45° FOV:
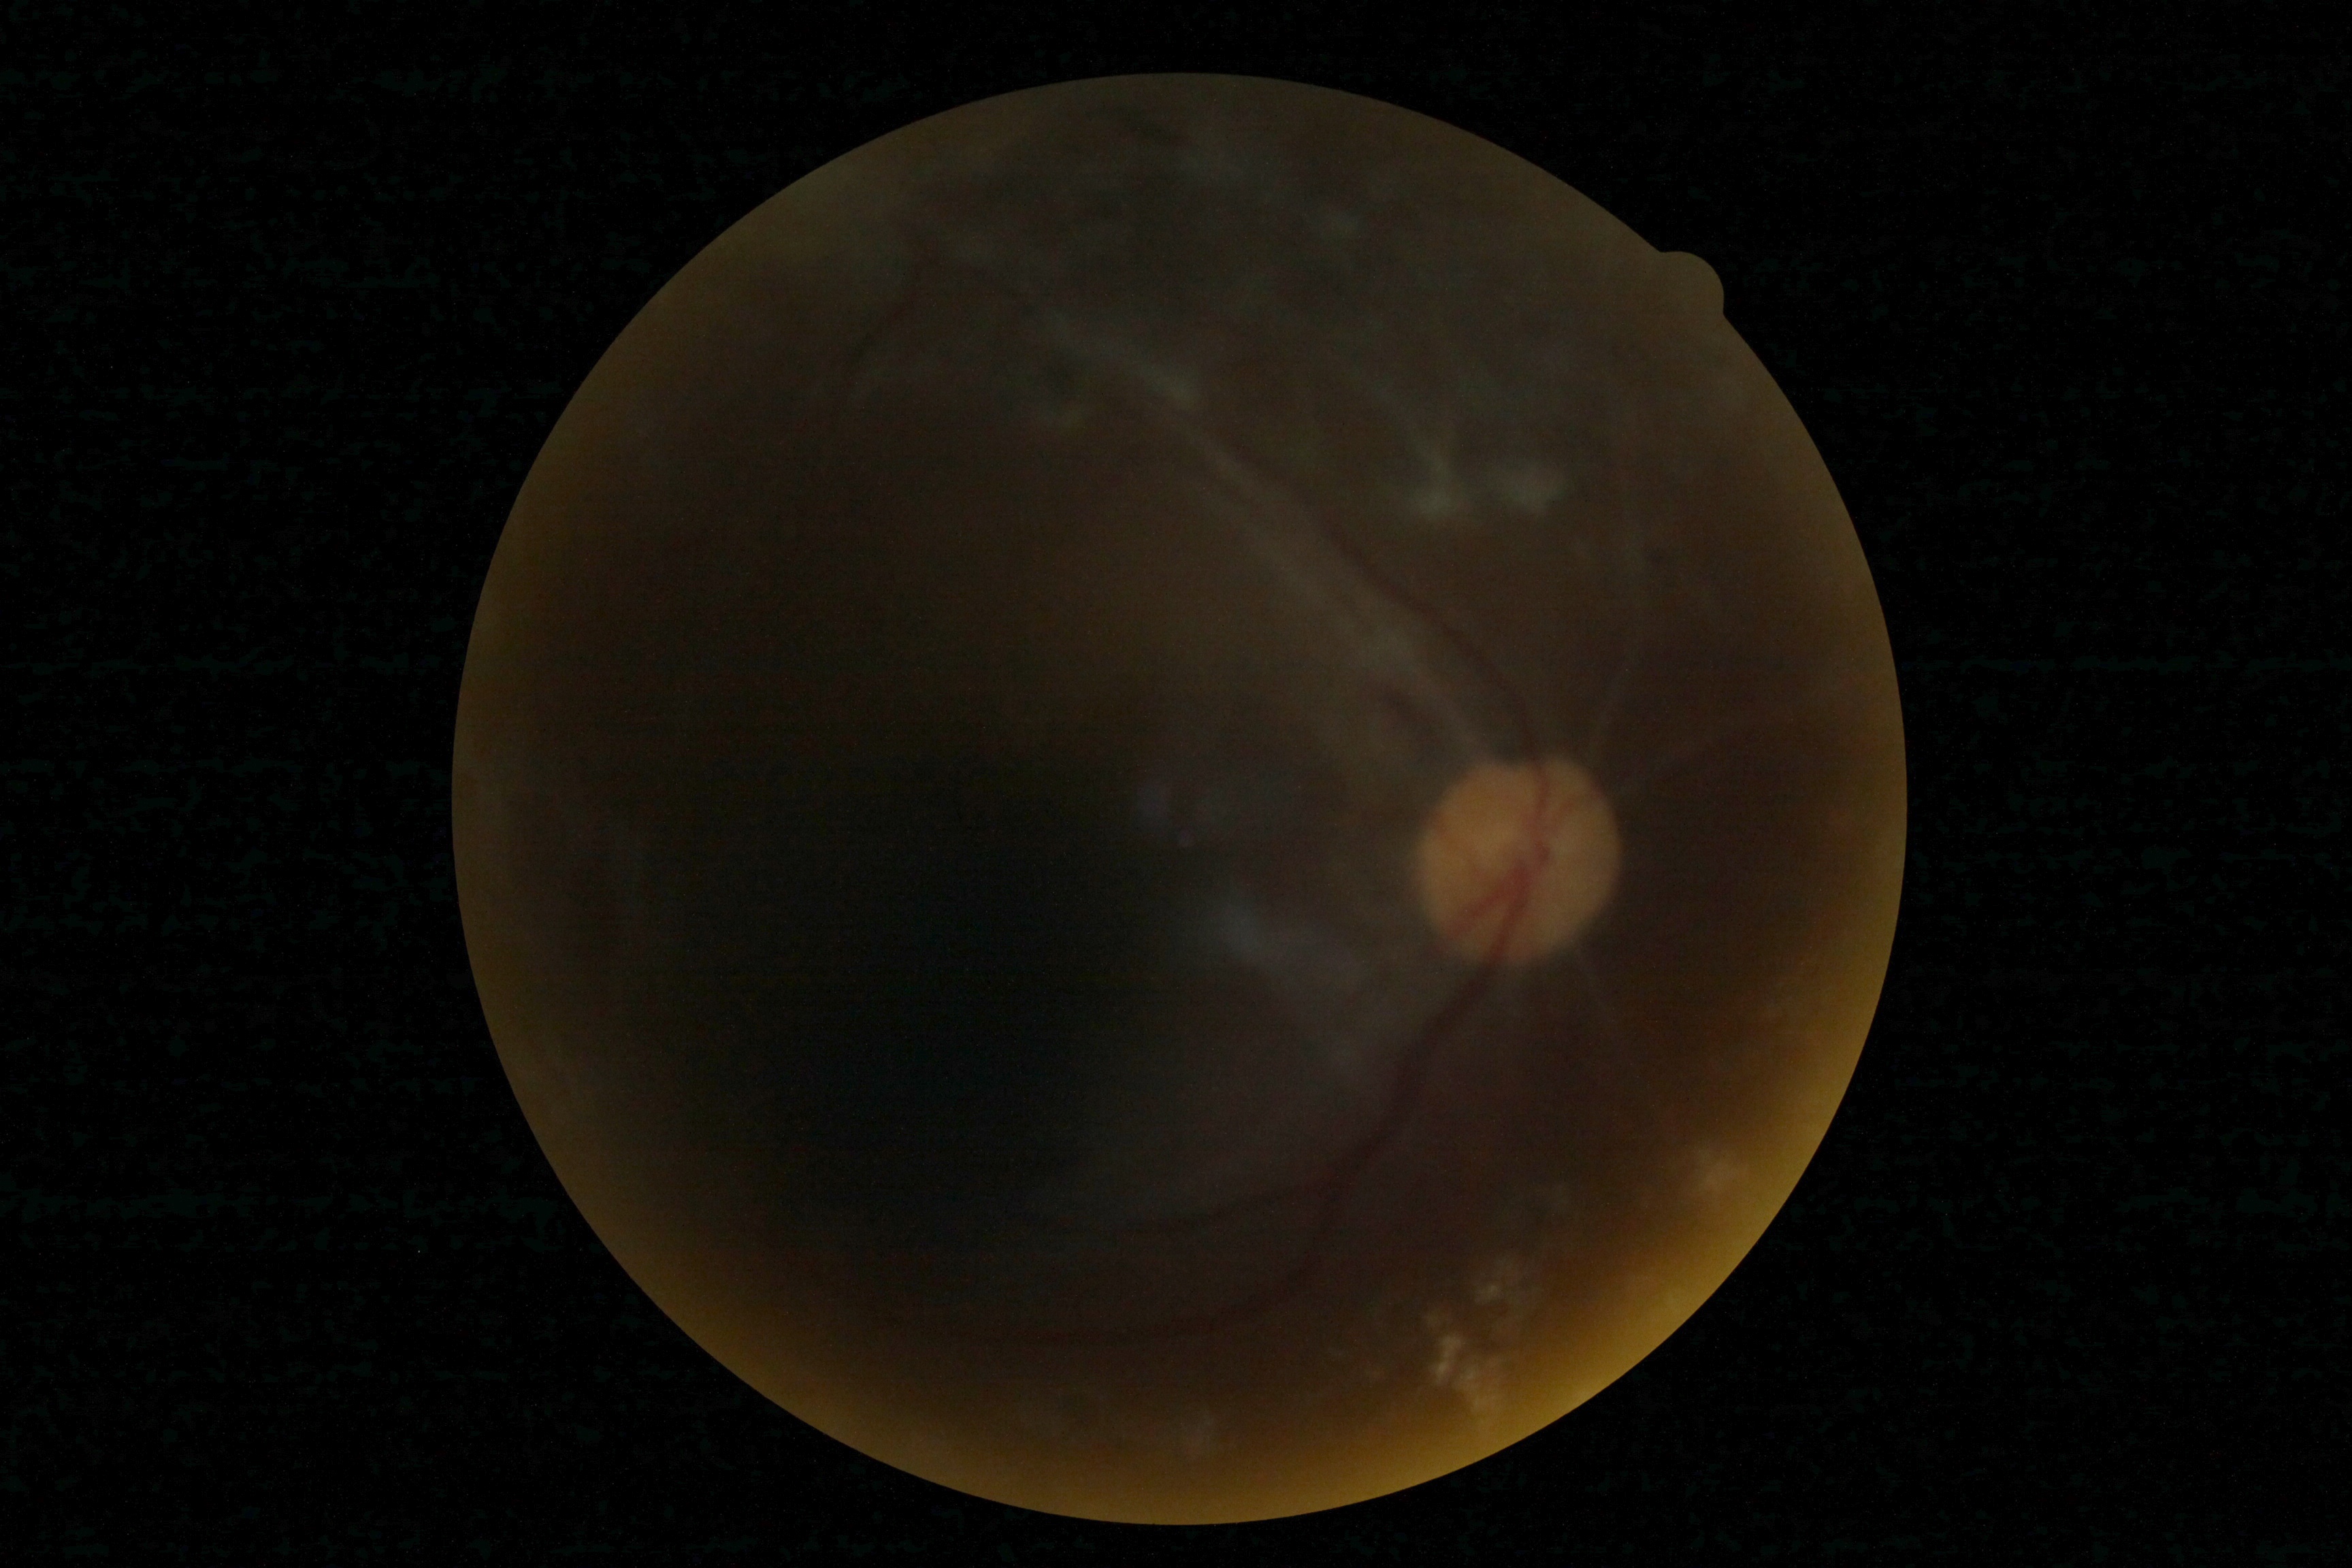

* DR grade — 4/4